Image size 848x848. Retinal fundus photograph. Graded on the modified Davis scale. No pharmacologic dilation: 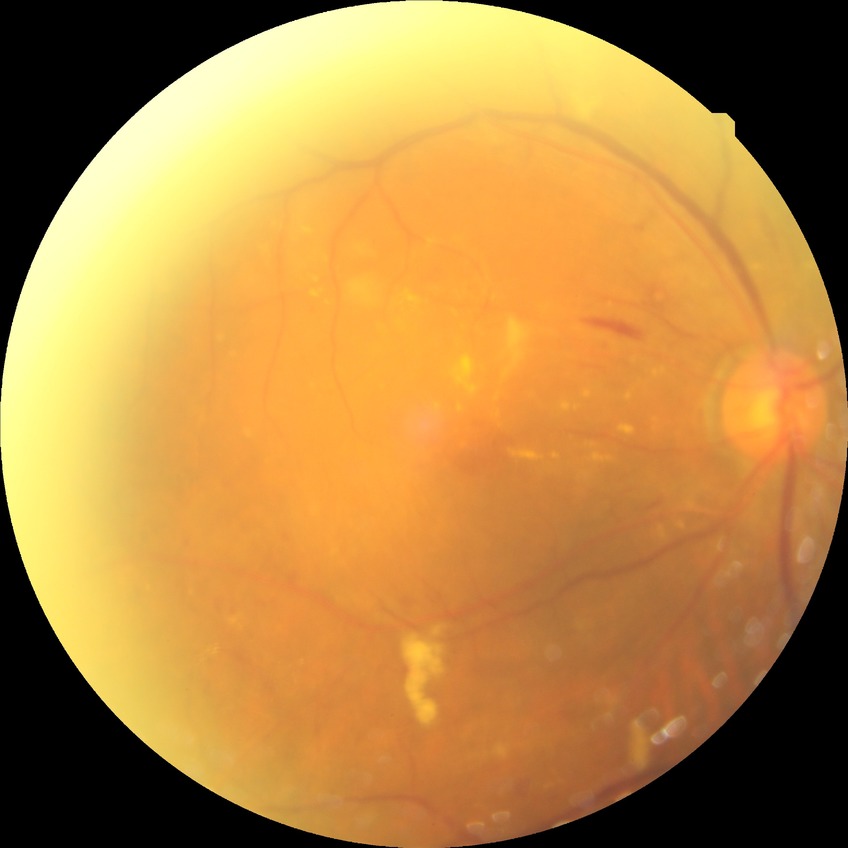 Assessment:
- diabetic retinopathy (DR) — PPDR (pre-proliferative diabetic retinopathy)
- DR class — non-proliferative diabetic retinopathy